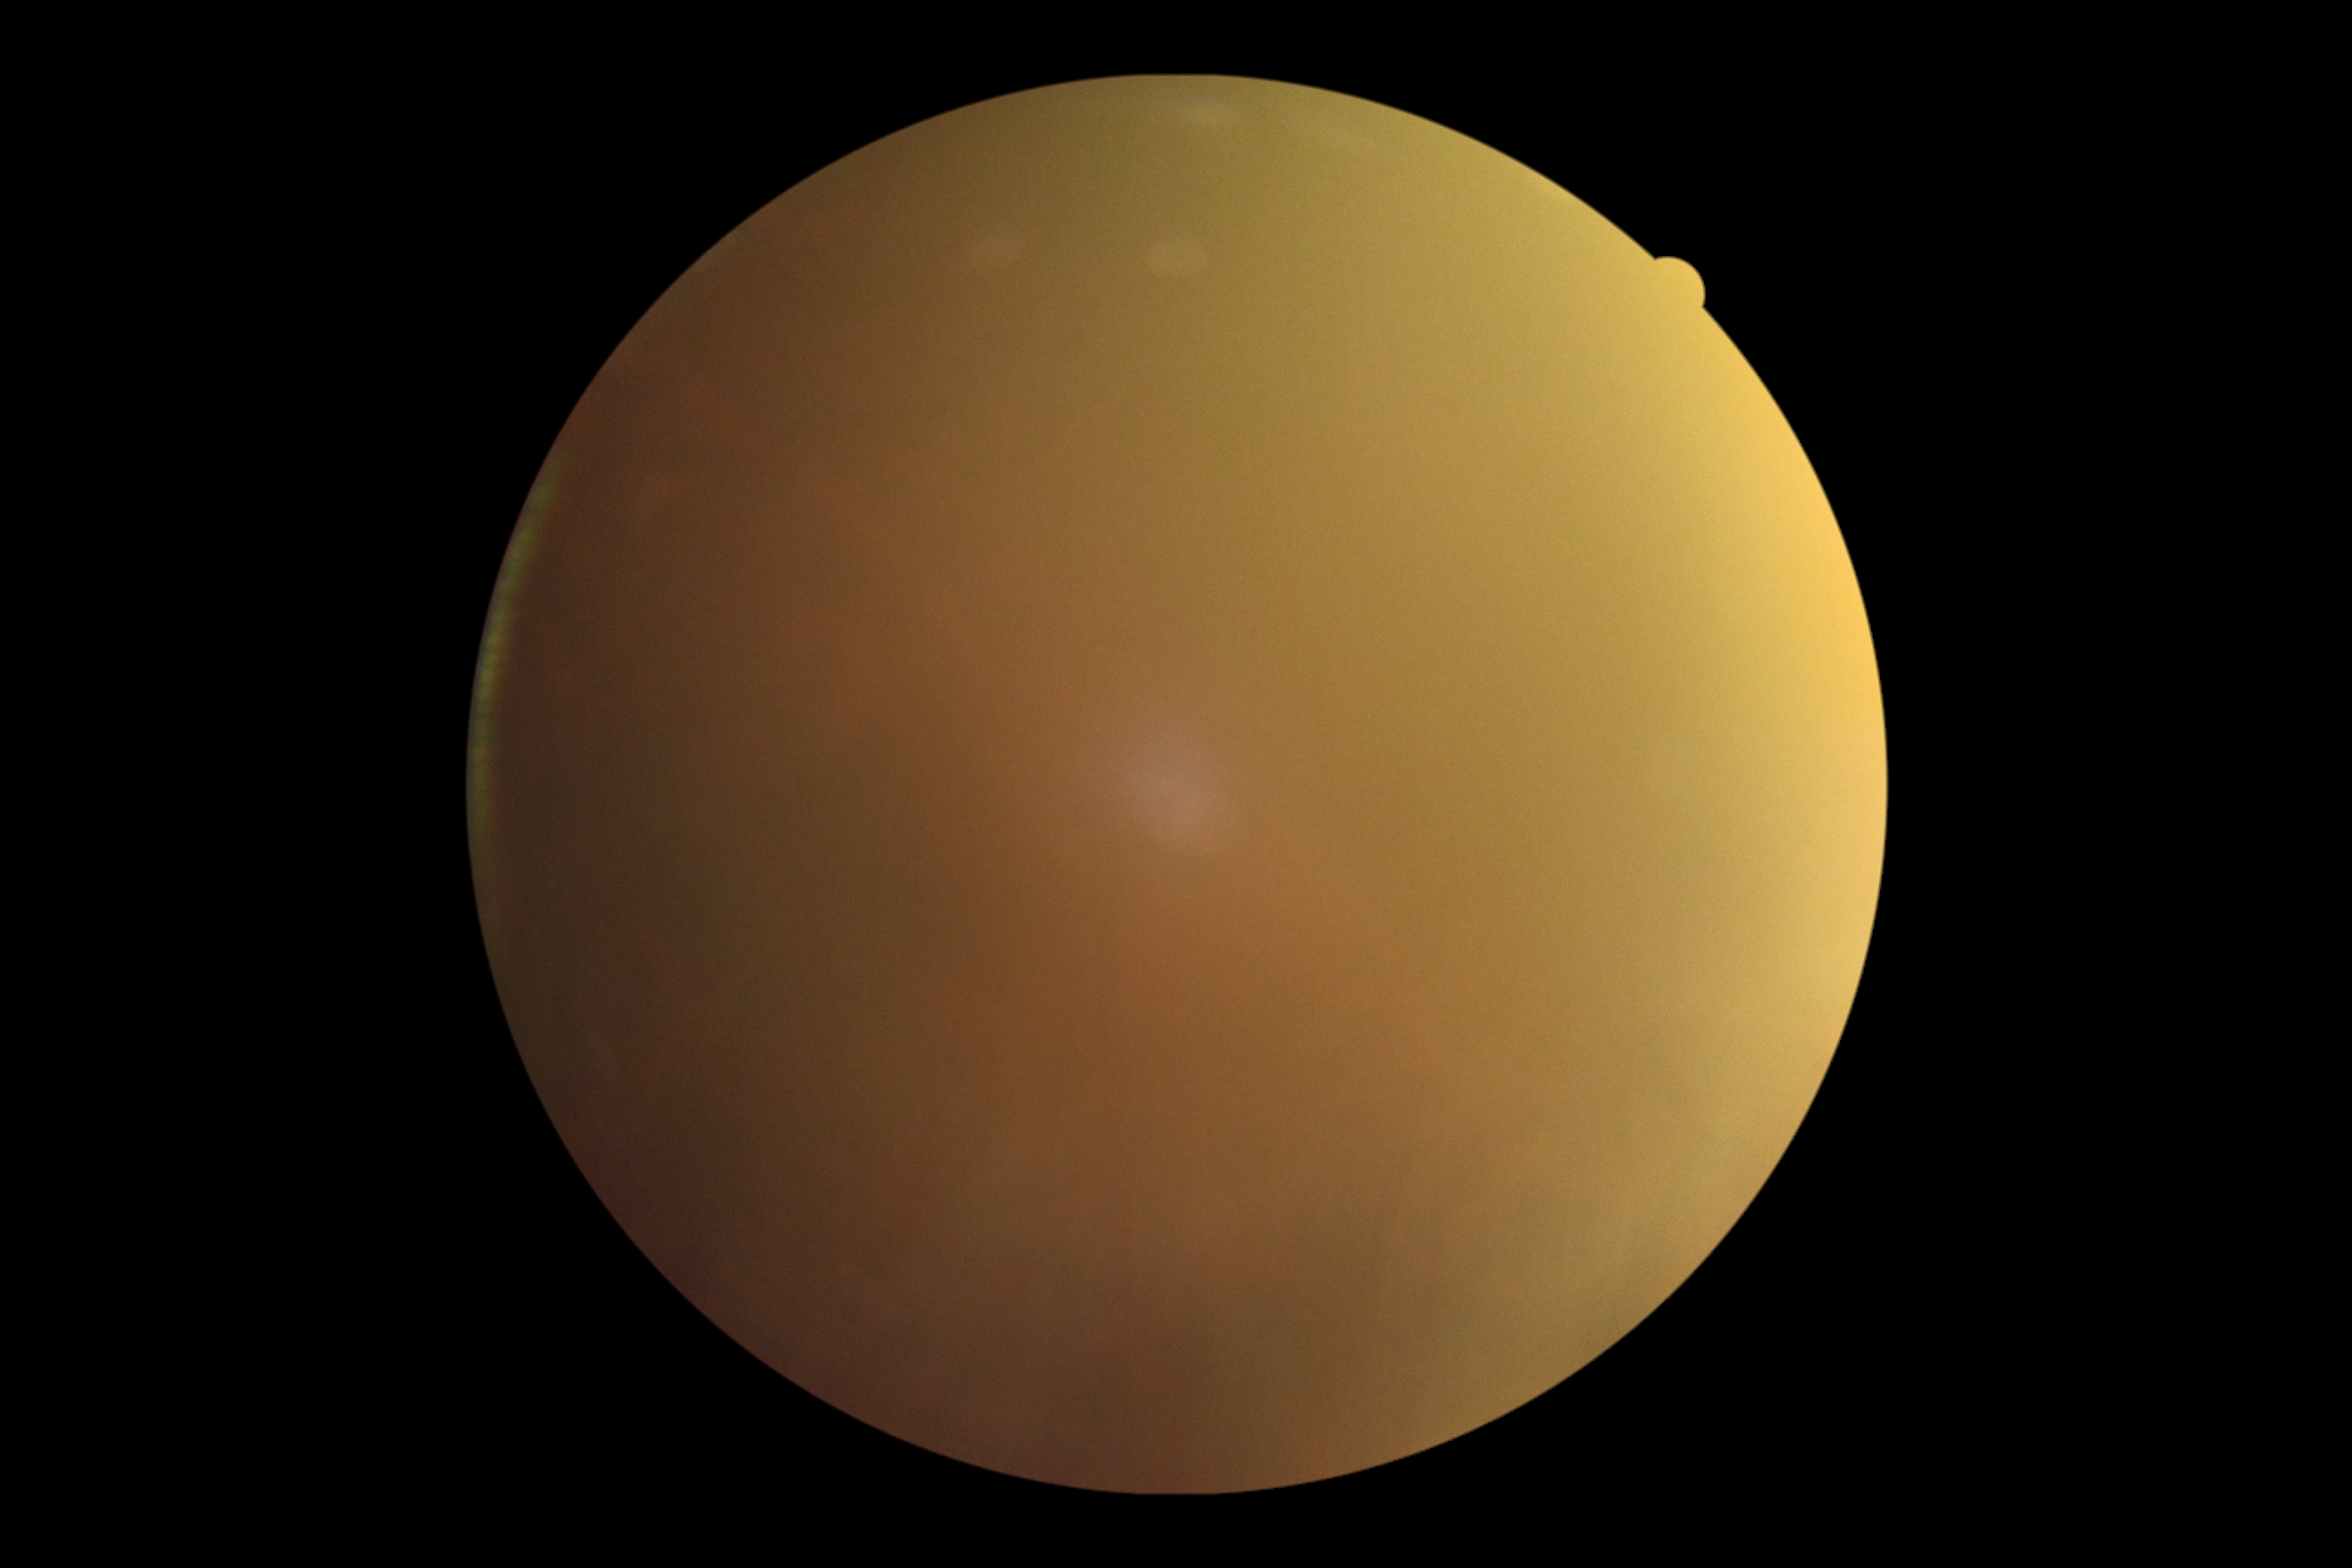 Quality too poor to assess for DR. Retinopathy: ungradable due to poor image quality.